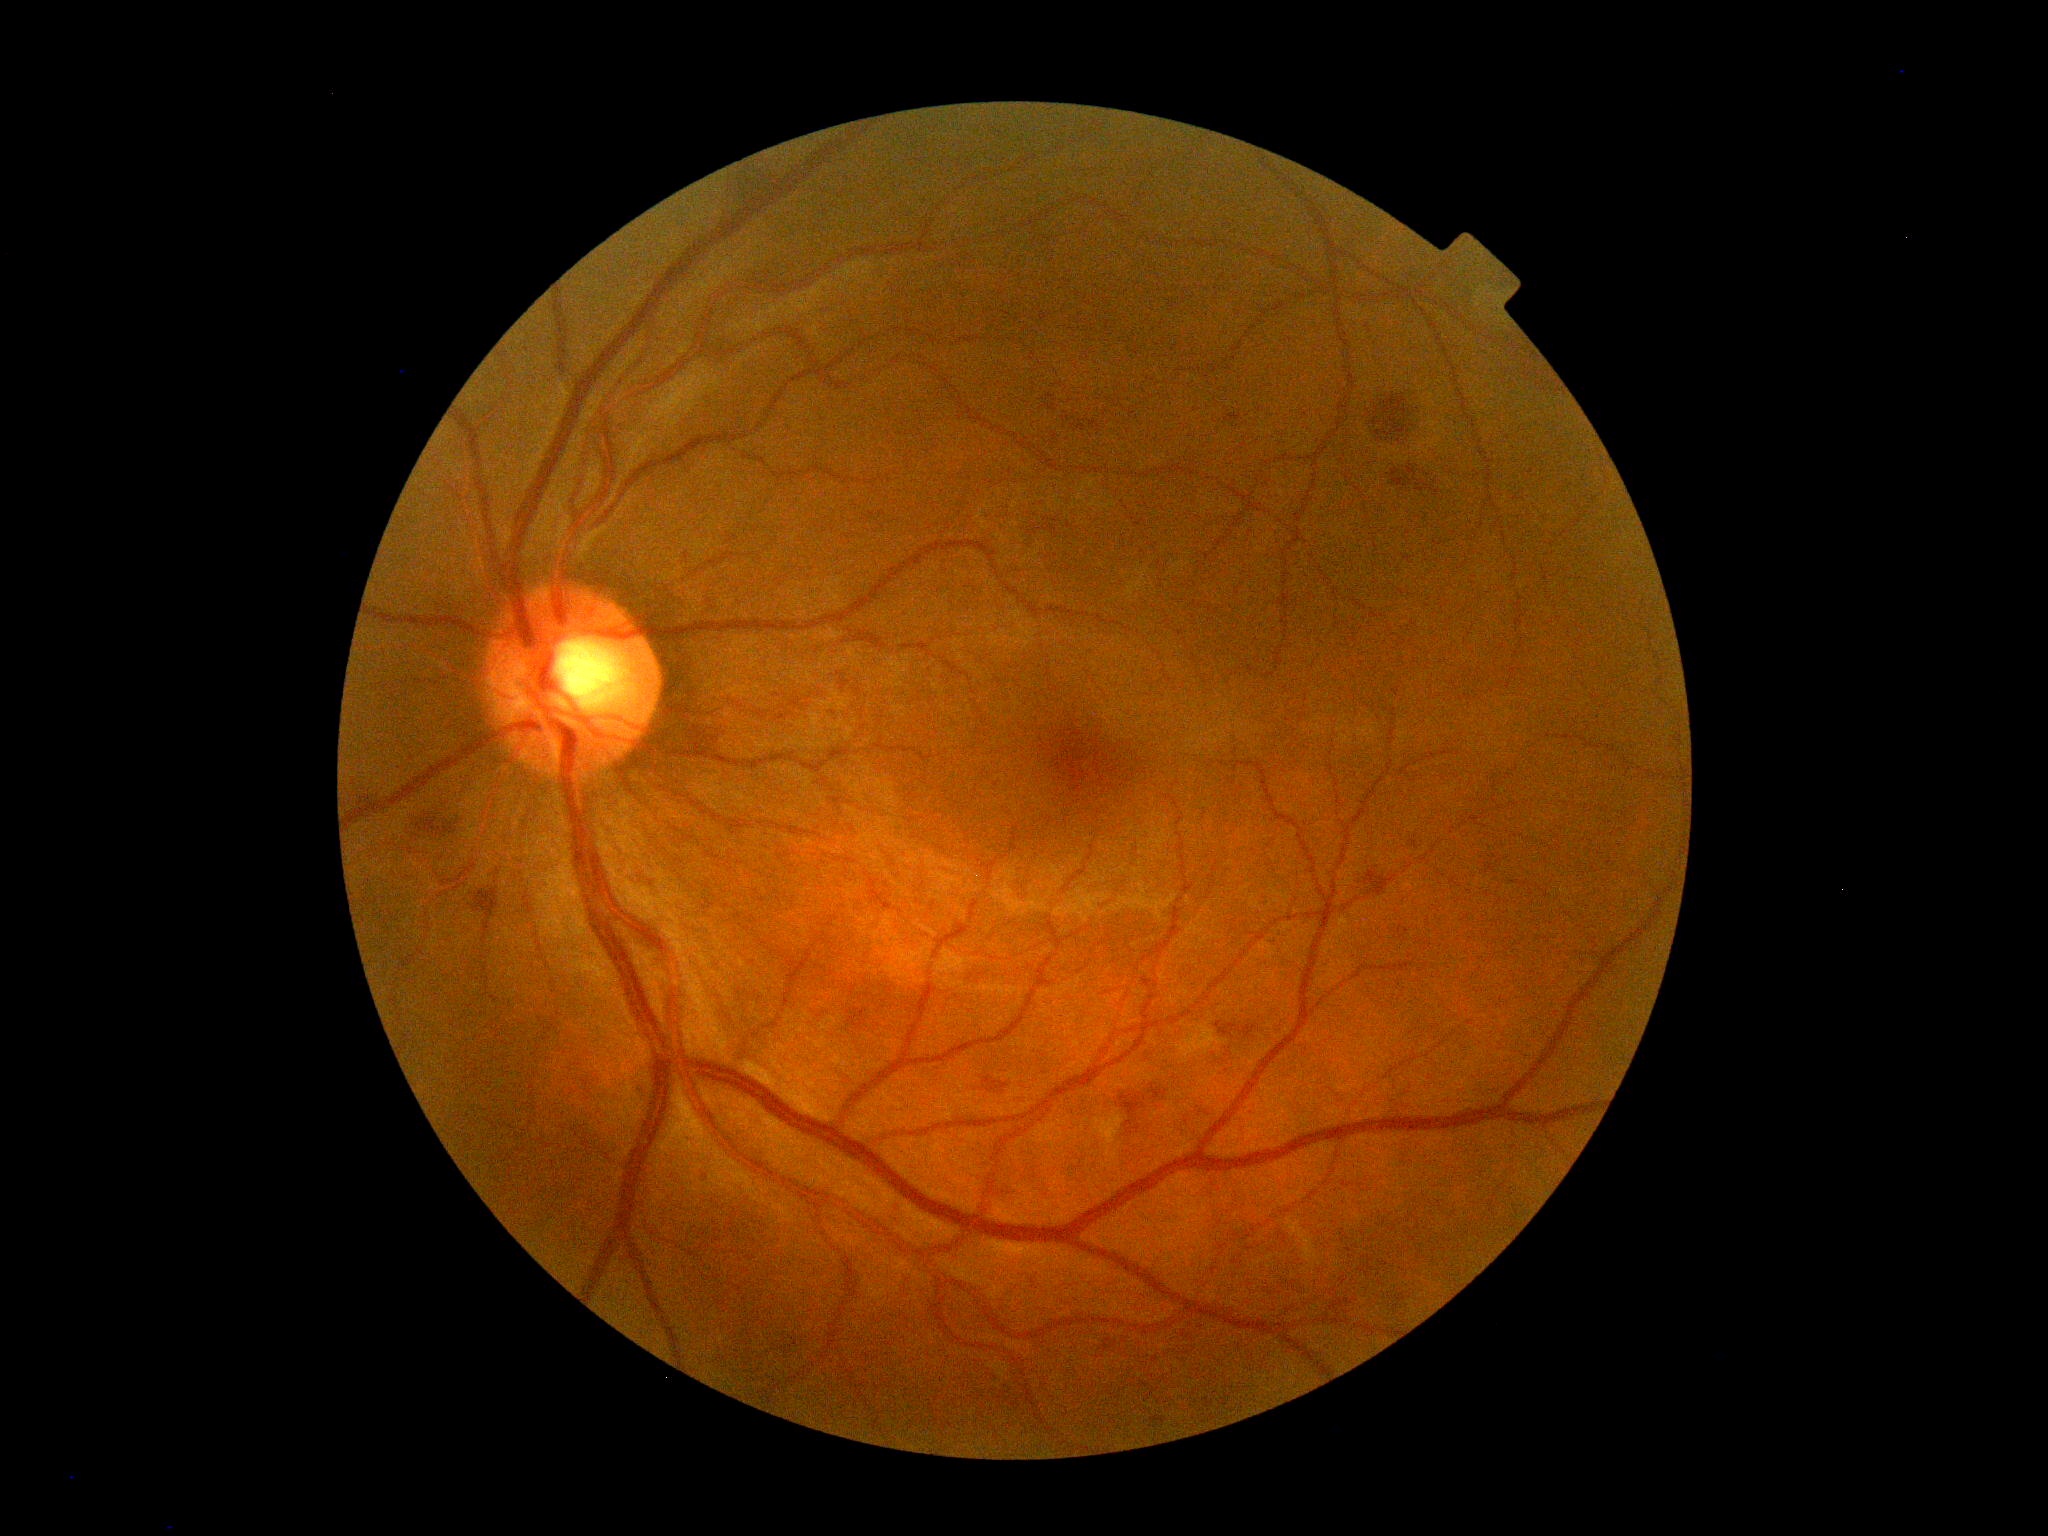 DR: grade 2 (moderate NPDR). DR class: non-proliferative diabetic retinopathy.